Acquired with a NIDEK AFC-230 · without pupil dilation — 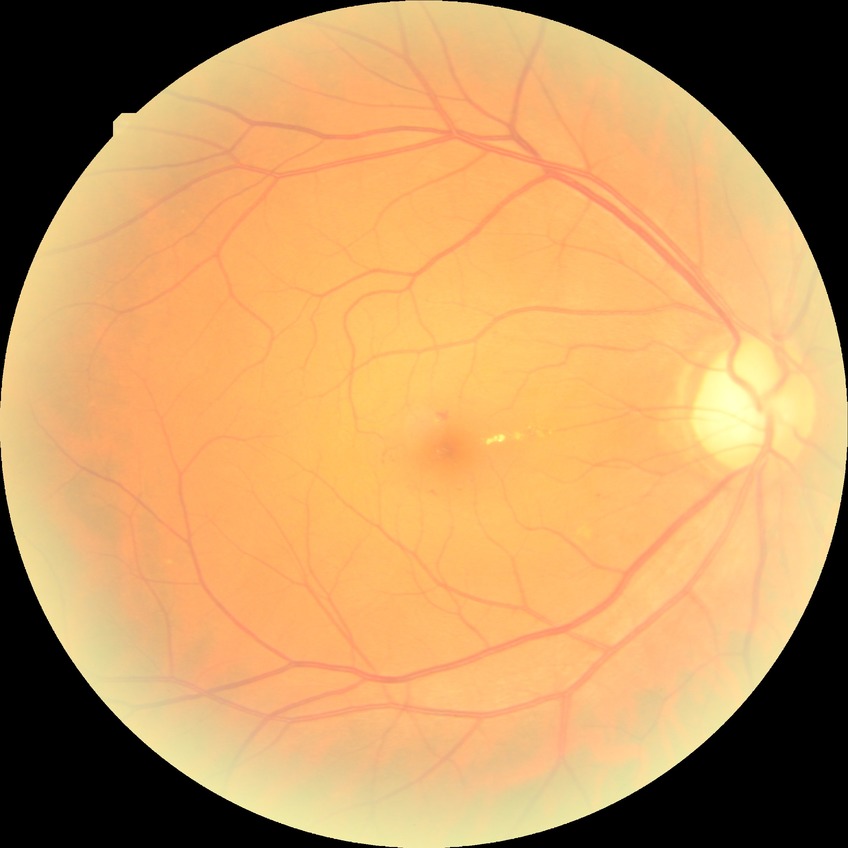 DR class: non-proliferative diabetic retinopathy. Diabetic retinopathy grade is simple diabetic retinopathy.